Gender: M · central corneal thickness: 491 µm · intraocular pressure 21.5 mmHg (pneumatic tonometry) · image size 2212x1661 · centered on the optic disc
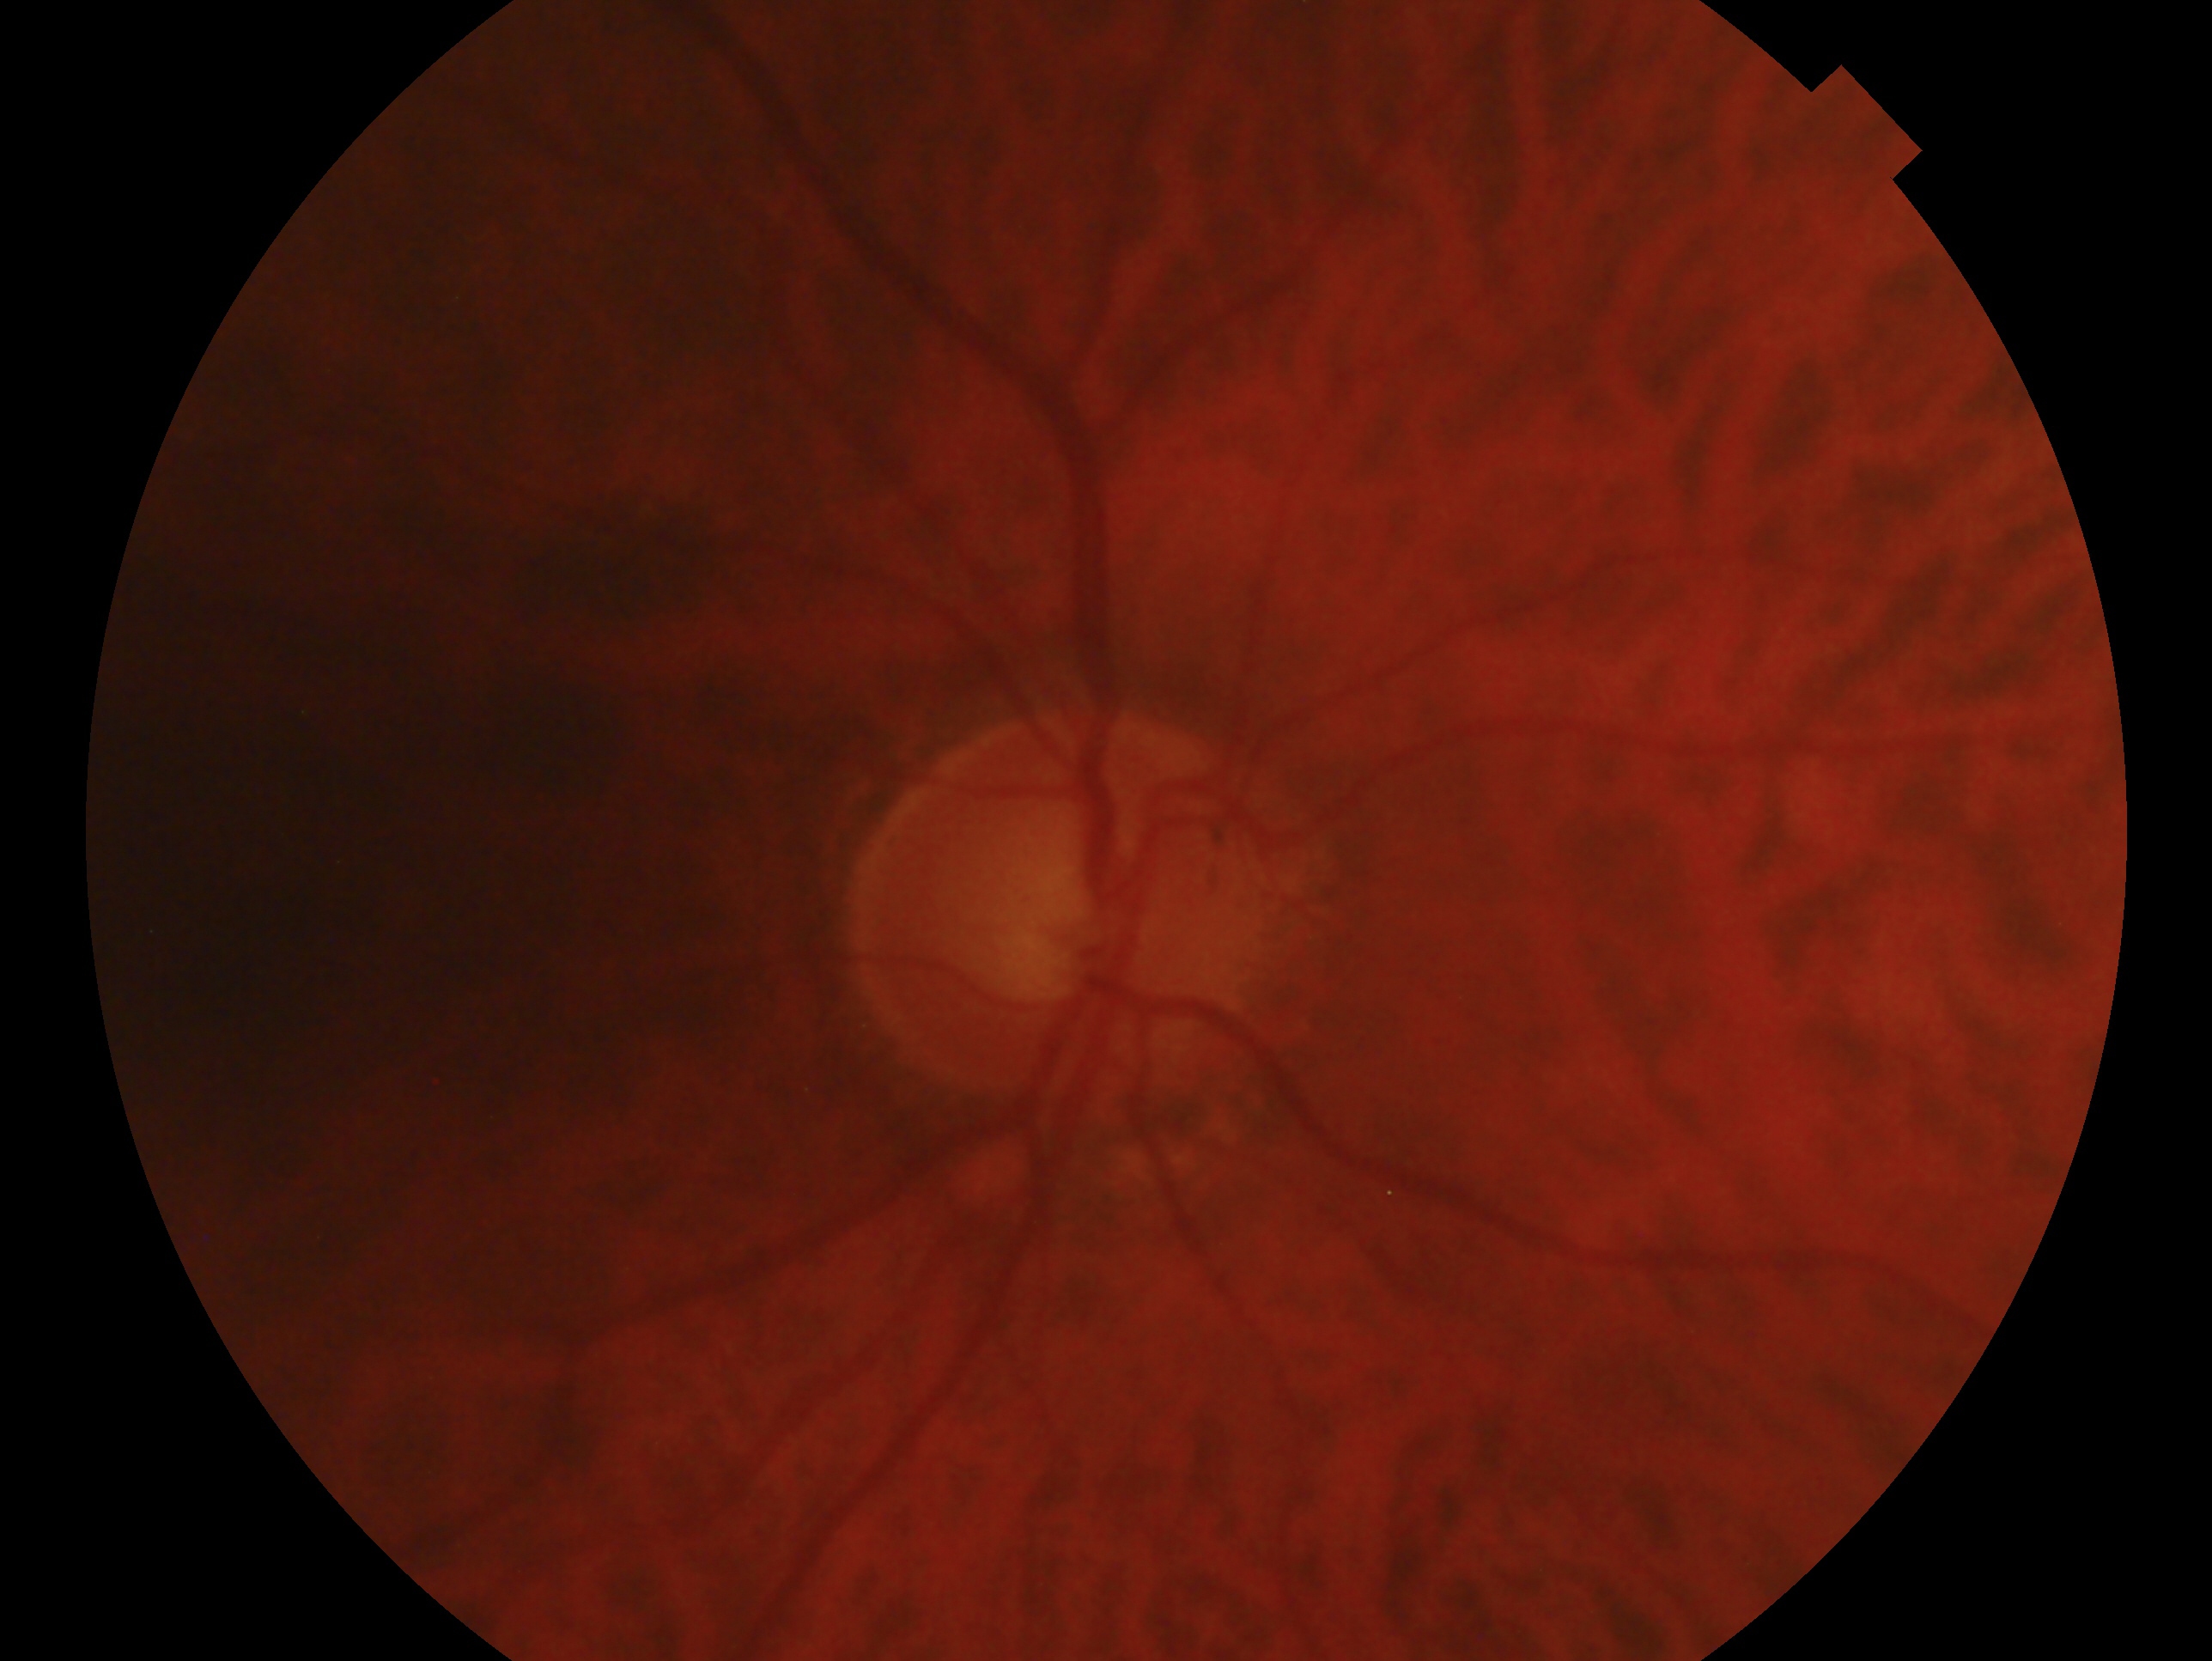
Impression — no signs of glaucoma. This is the right eye.